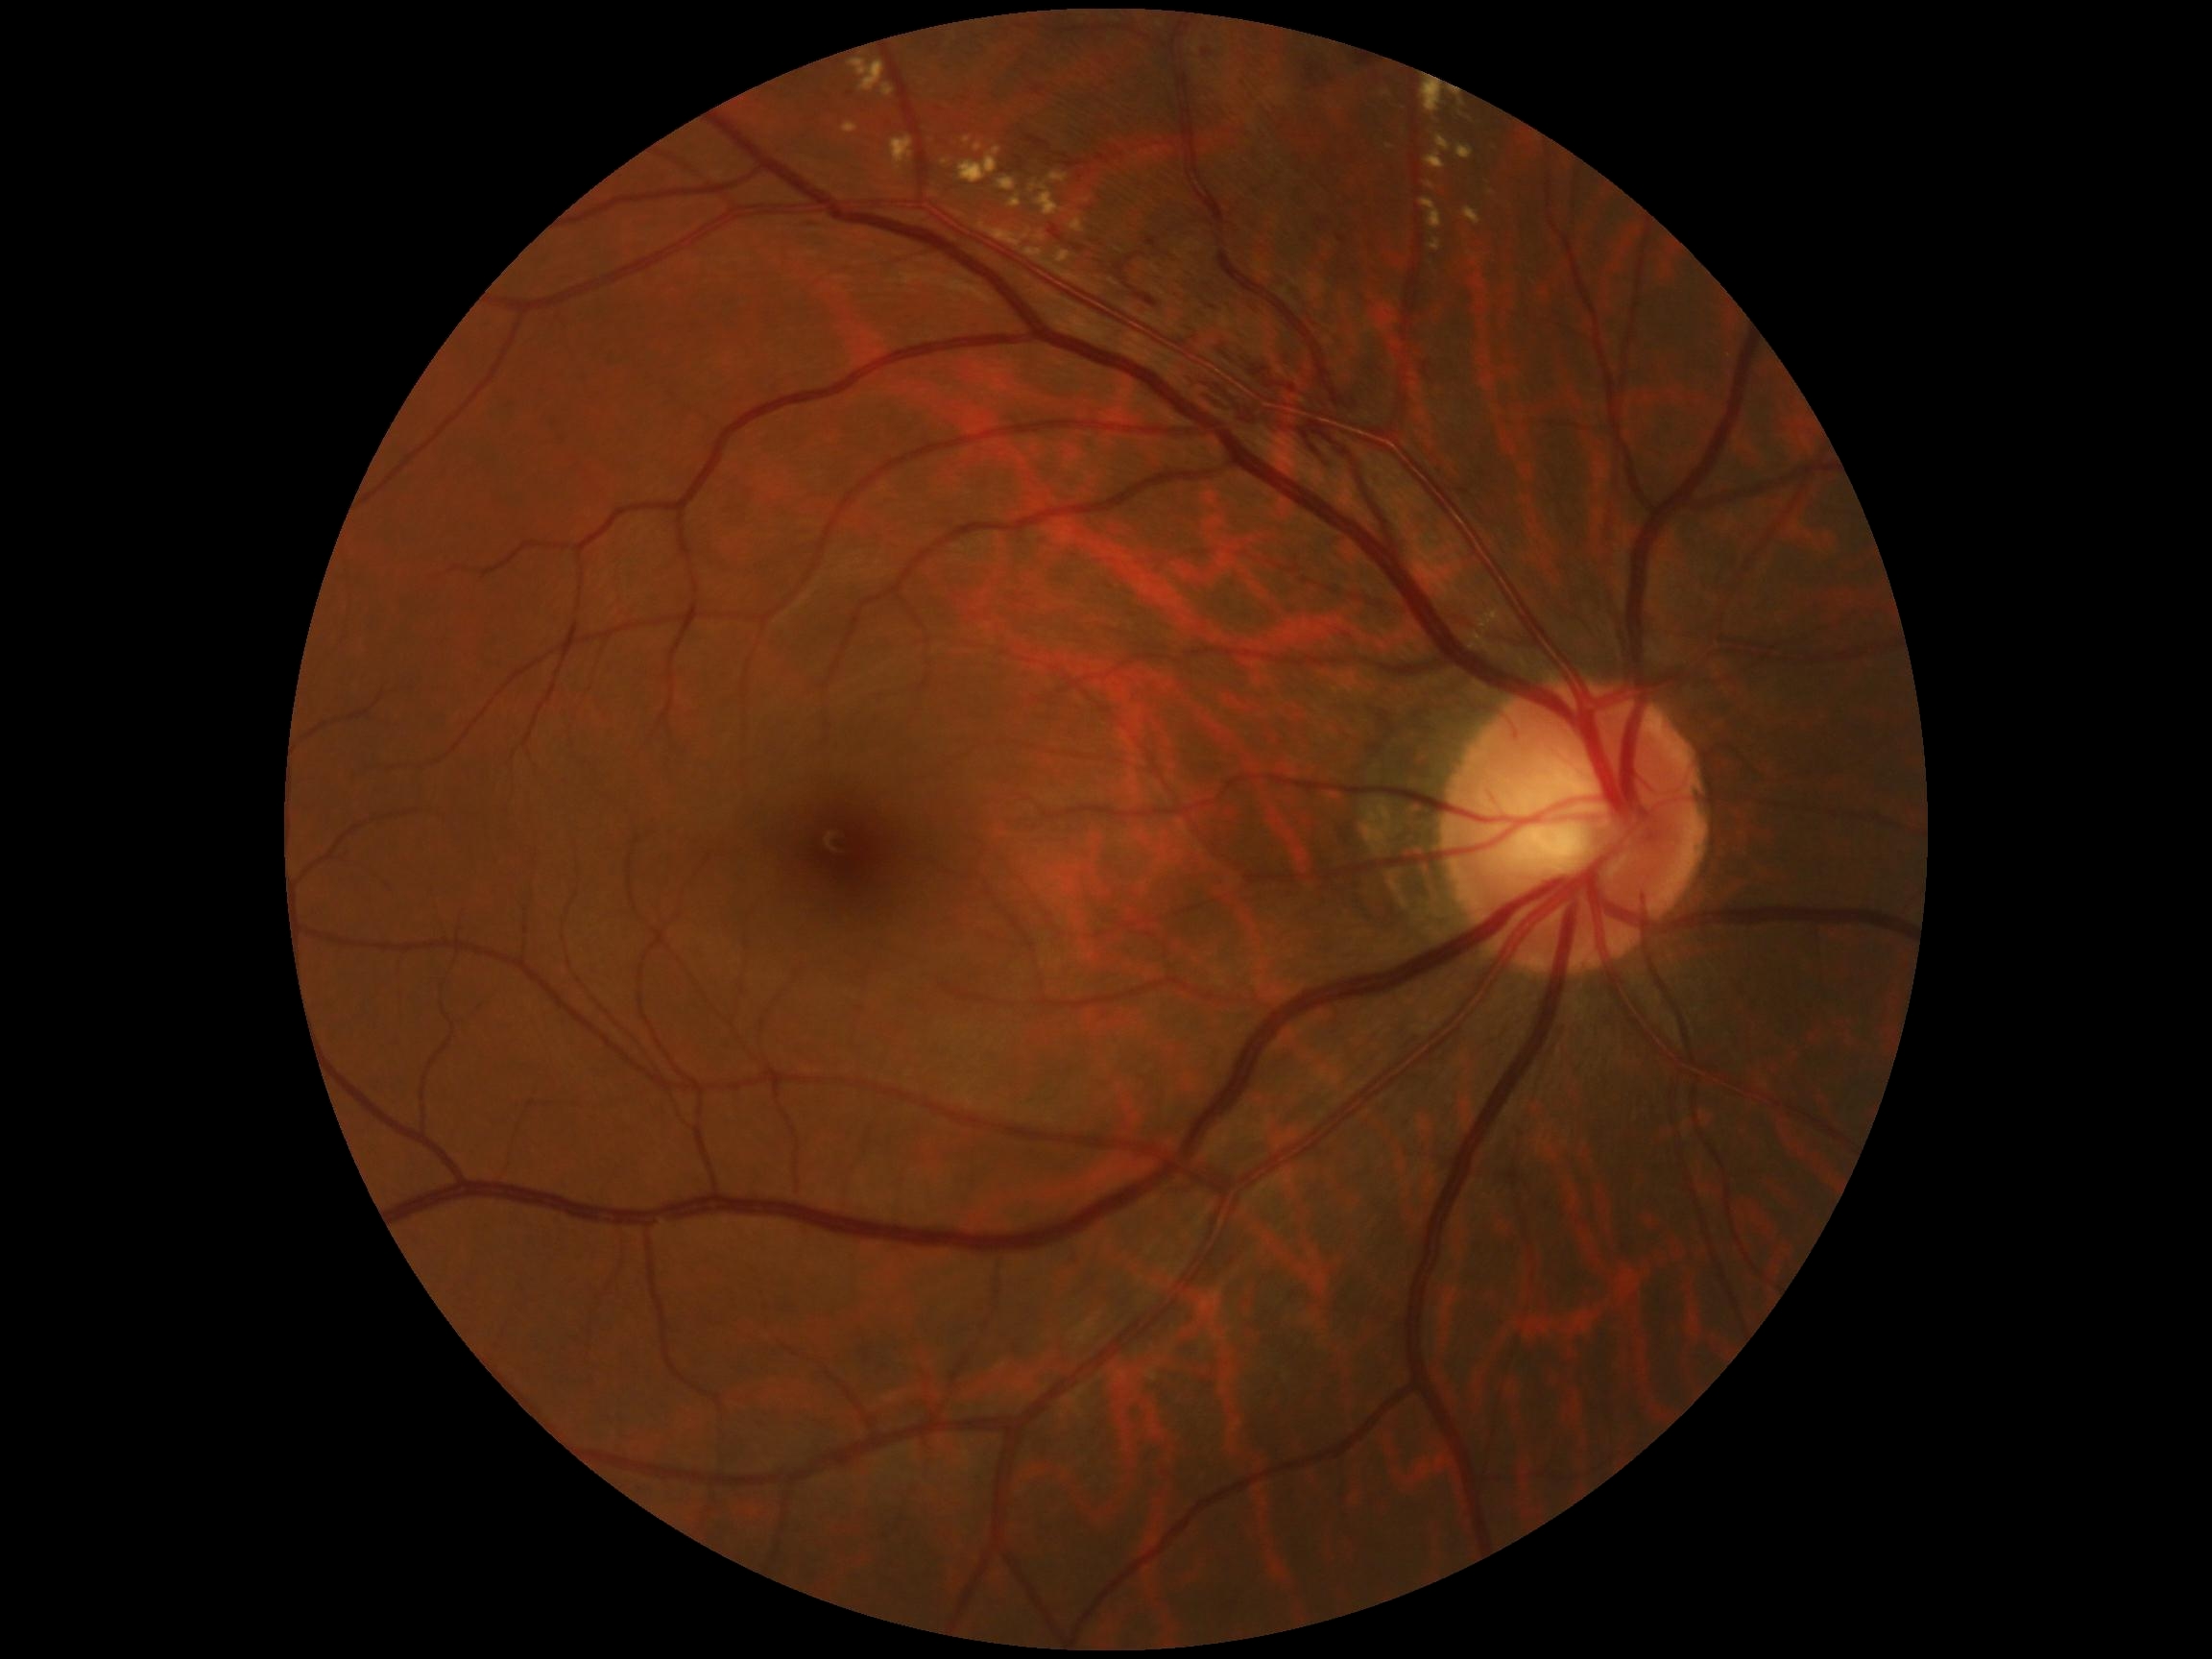 Diabetic retinopathy: grade 2 (moderate NPDR)
Lesions identified (partial list):
• soft exudates: none identified
• microaneurysms: none identified
• hemorrhages (more not shown): Rect(1032, 85, 1046, 97) | Rect(1096, 155, 1111, 164) | Rect(1338, 238, 1347, 243) | Rect(1027, 135, 1048, 149) | Rect(1220, 346, 1313, 399) | Rect(1294, 429, 1335, 469) | Rect(1116, 264, 1125, 276) | Rect(1117, 150, 1123, 158) | Rect(1307, 65, 1321, 81) | Rect(1016, 156, 1024, 164) | Rect(1201, 300, 1226, 319)
• Small hemorrhages near Point(1066, 157)
• hard exudates (more not shown): Rect(891, 137, 913, 174) | Rect(1422, 83, 1443, 113) | Rect(1479, 608, 1503, 624) | Rect(1070, 219, 1085, 233) | Rect(963, 137, 971, 144) | Rect(1030, 182, 1064, 216) | Rect(960, 147, 1001, 185) | Rect(1025, 250, 1044, 257) | Rect(1476, 625, 1486, 651) | Rect(1427, 182, 1435, 190) | Rect(1457, 145, 1474, 159) | Rect(997, 176, 1018, 192) | Rect(882, 84, 896, 97) | Rect(1009, 195, 1022, 209) | Rect(1381, 92, 1390, 97)
• Small hard exudates near Point(1026, 237)